NIDEK AFC-230 fundus camera · 45° field of view · 848 x 848 pixels · posterior pole color fundus photograph.
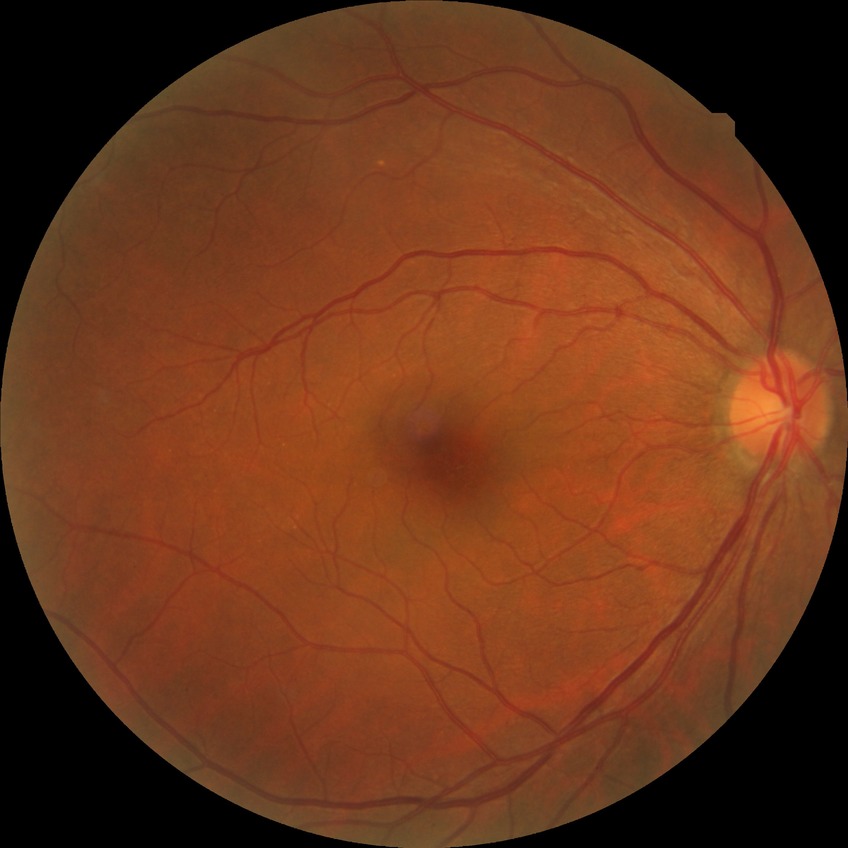

Diabetic retinopathy (DR): NDR (no diabetic retinopathy).